Camera: NIDEK AFC-230:
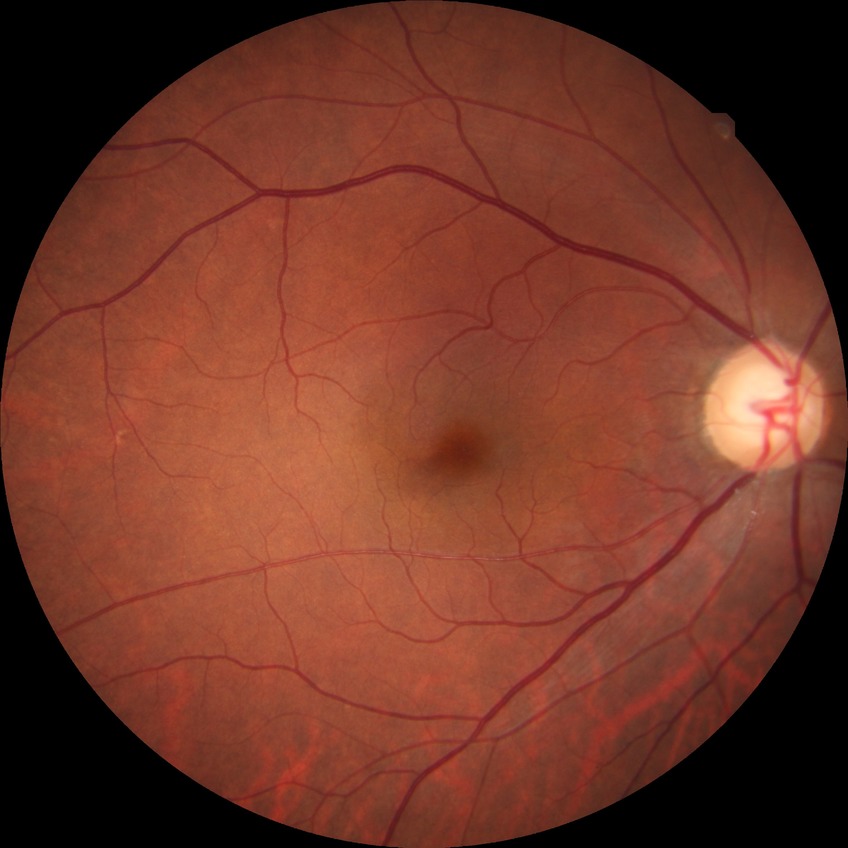

Diabetic retinopathy (DR) is no diabetic retinopathy (NDR).